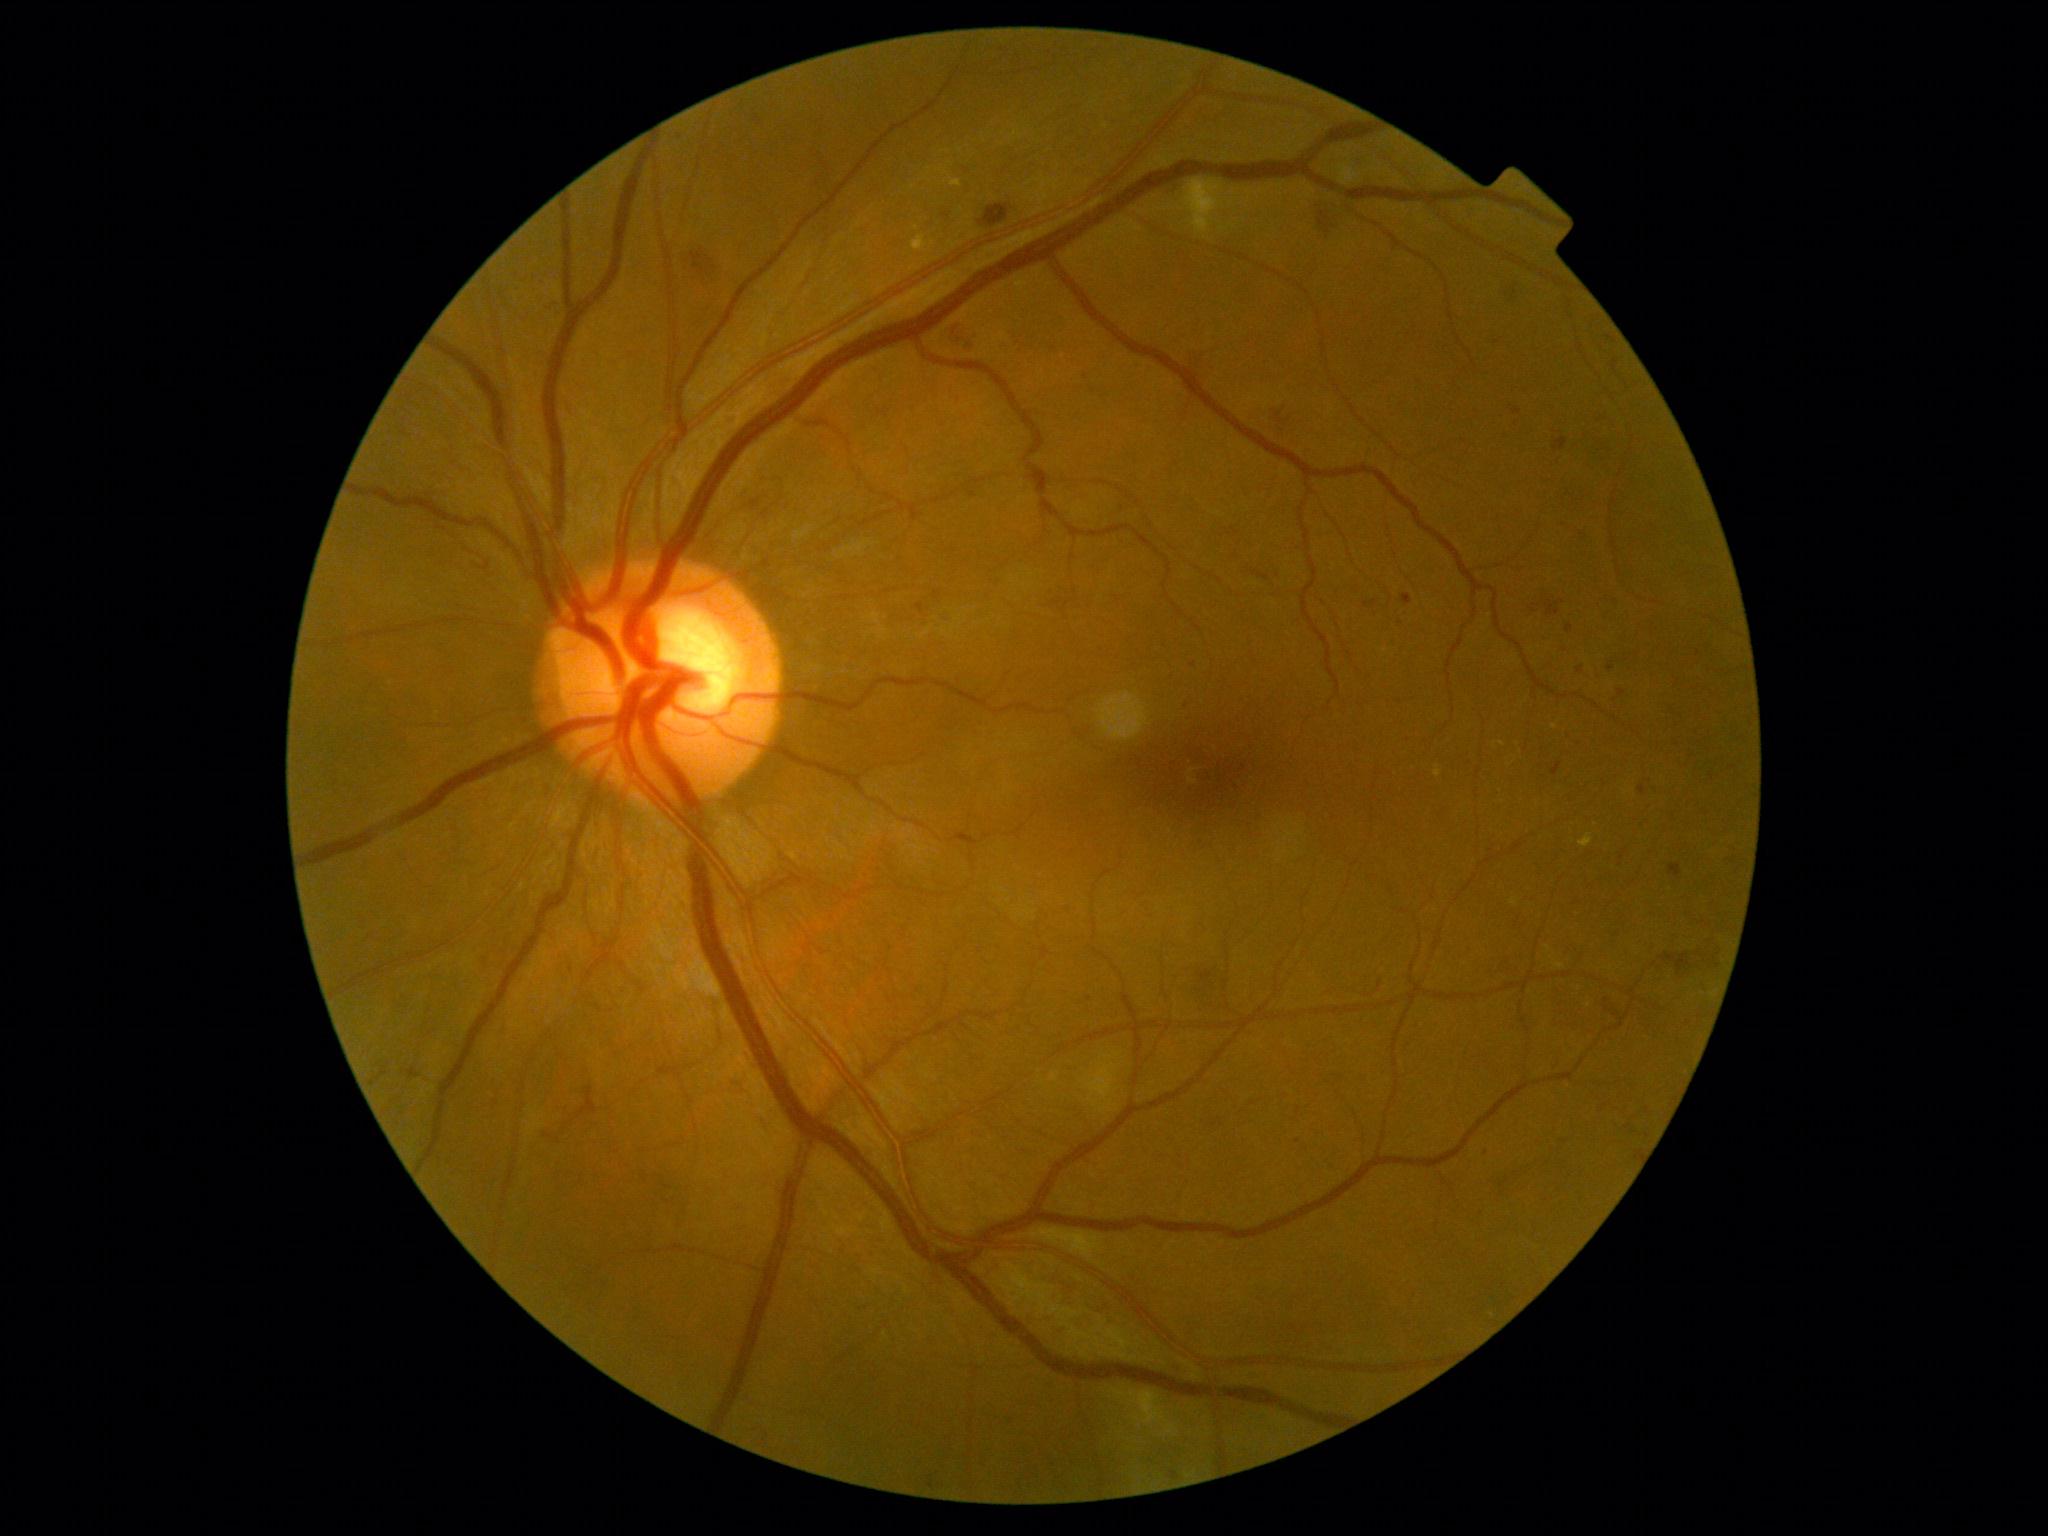

Diabetic retinopathy (DR) is grade 2
Representative lesions:
hard exudates (EXs) (more not shown) = 1555 964 1565 968; 951 180 962 187; 1435 765 1442 778; 912 236 929 252; 1579 834 1594 847; 1510 898 1517 906
Small EXs near <pt>917,228</pt>; <pt>1503,744</pt>; <pt>1555,727</pt>; <pt>1548,948</pt>
microaneurysms (MAs) (more not shown) = 935 592 942 601; 1618 690 1626 697; 754 115 762 122; 966 490 978 498; 1566 625 1574 634; 1669 865 1682 878; 1364 601 1377 608; 1177 1366 1186 1375; 1607 335 1617 343; 408 1068 420 1079; 1503 284 1523 301
Small MAs near <pt>1194,665</pt>; <pt>1613,601</pt>; <pt>1086,376</pt>; <pt>1090,999</pt>
hemorrhages (HEs) = 691 239 714 281; 1263 397 1298 431; 979 206 1010 227; 1597 989 1624 1023; 1191 970 1226 1013; 951 325 978 353; 1496 1162 1530 1196; 1190 347 1209 367; 1664 937 1719 976; 1551 986 1584 1029; 1311 199 1341 236; 1529 591 1569 618
soft exudates (SEs) (more not shown) = 1051 1074 1059 1082; 1104 1055 1113 1059; 692 967 722 997; 1183 178 1223 236; 1031 1228 1102 1258; 795 526 813 540; 1085 1063 1118 1108; 1337 162 1357 186; 837 542 870 559; 1109 1388 1167 1425; 1101 1100 1115 1112
Small SEs near <pt>1118,1055</pt>; <pt>1117,1089</pt>